Color fundus image
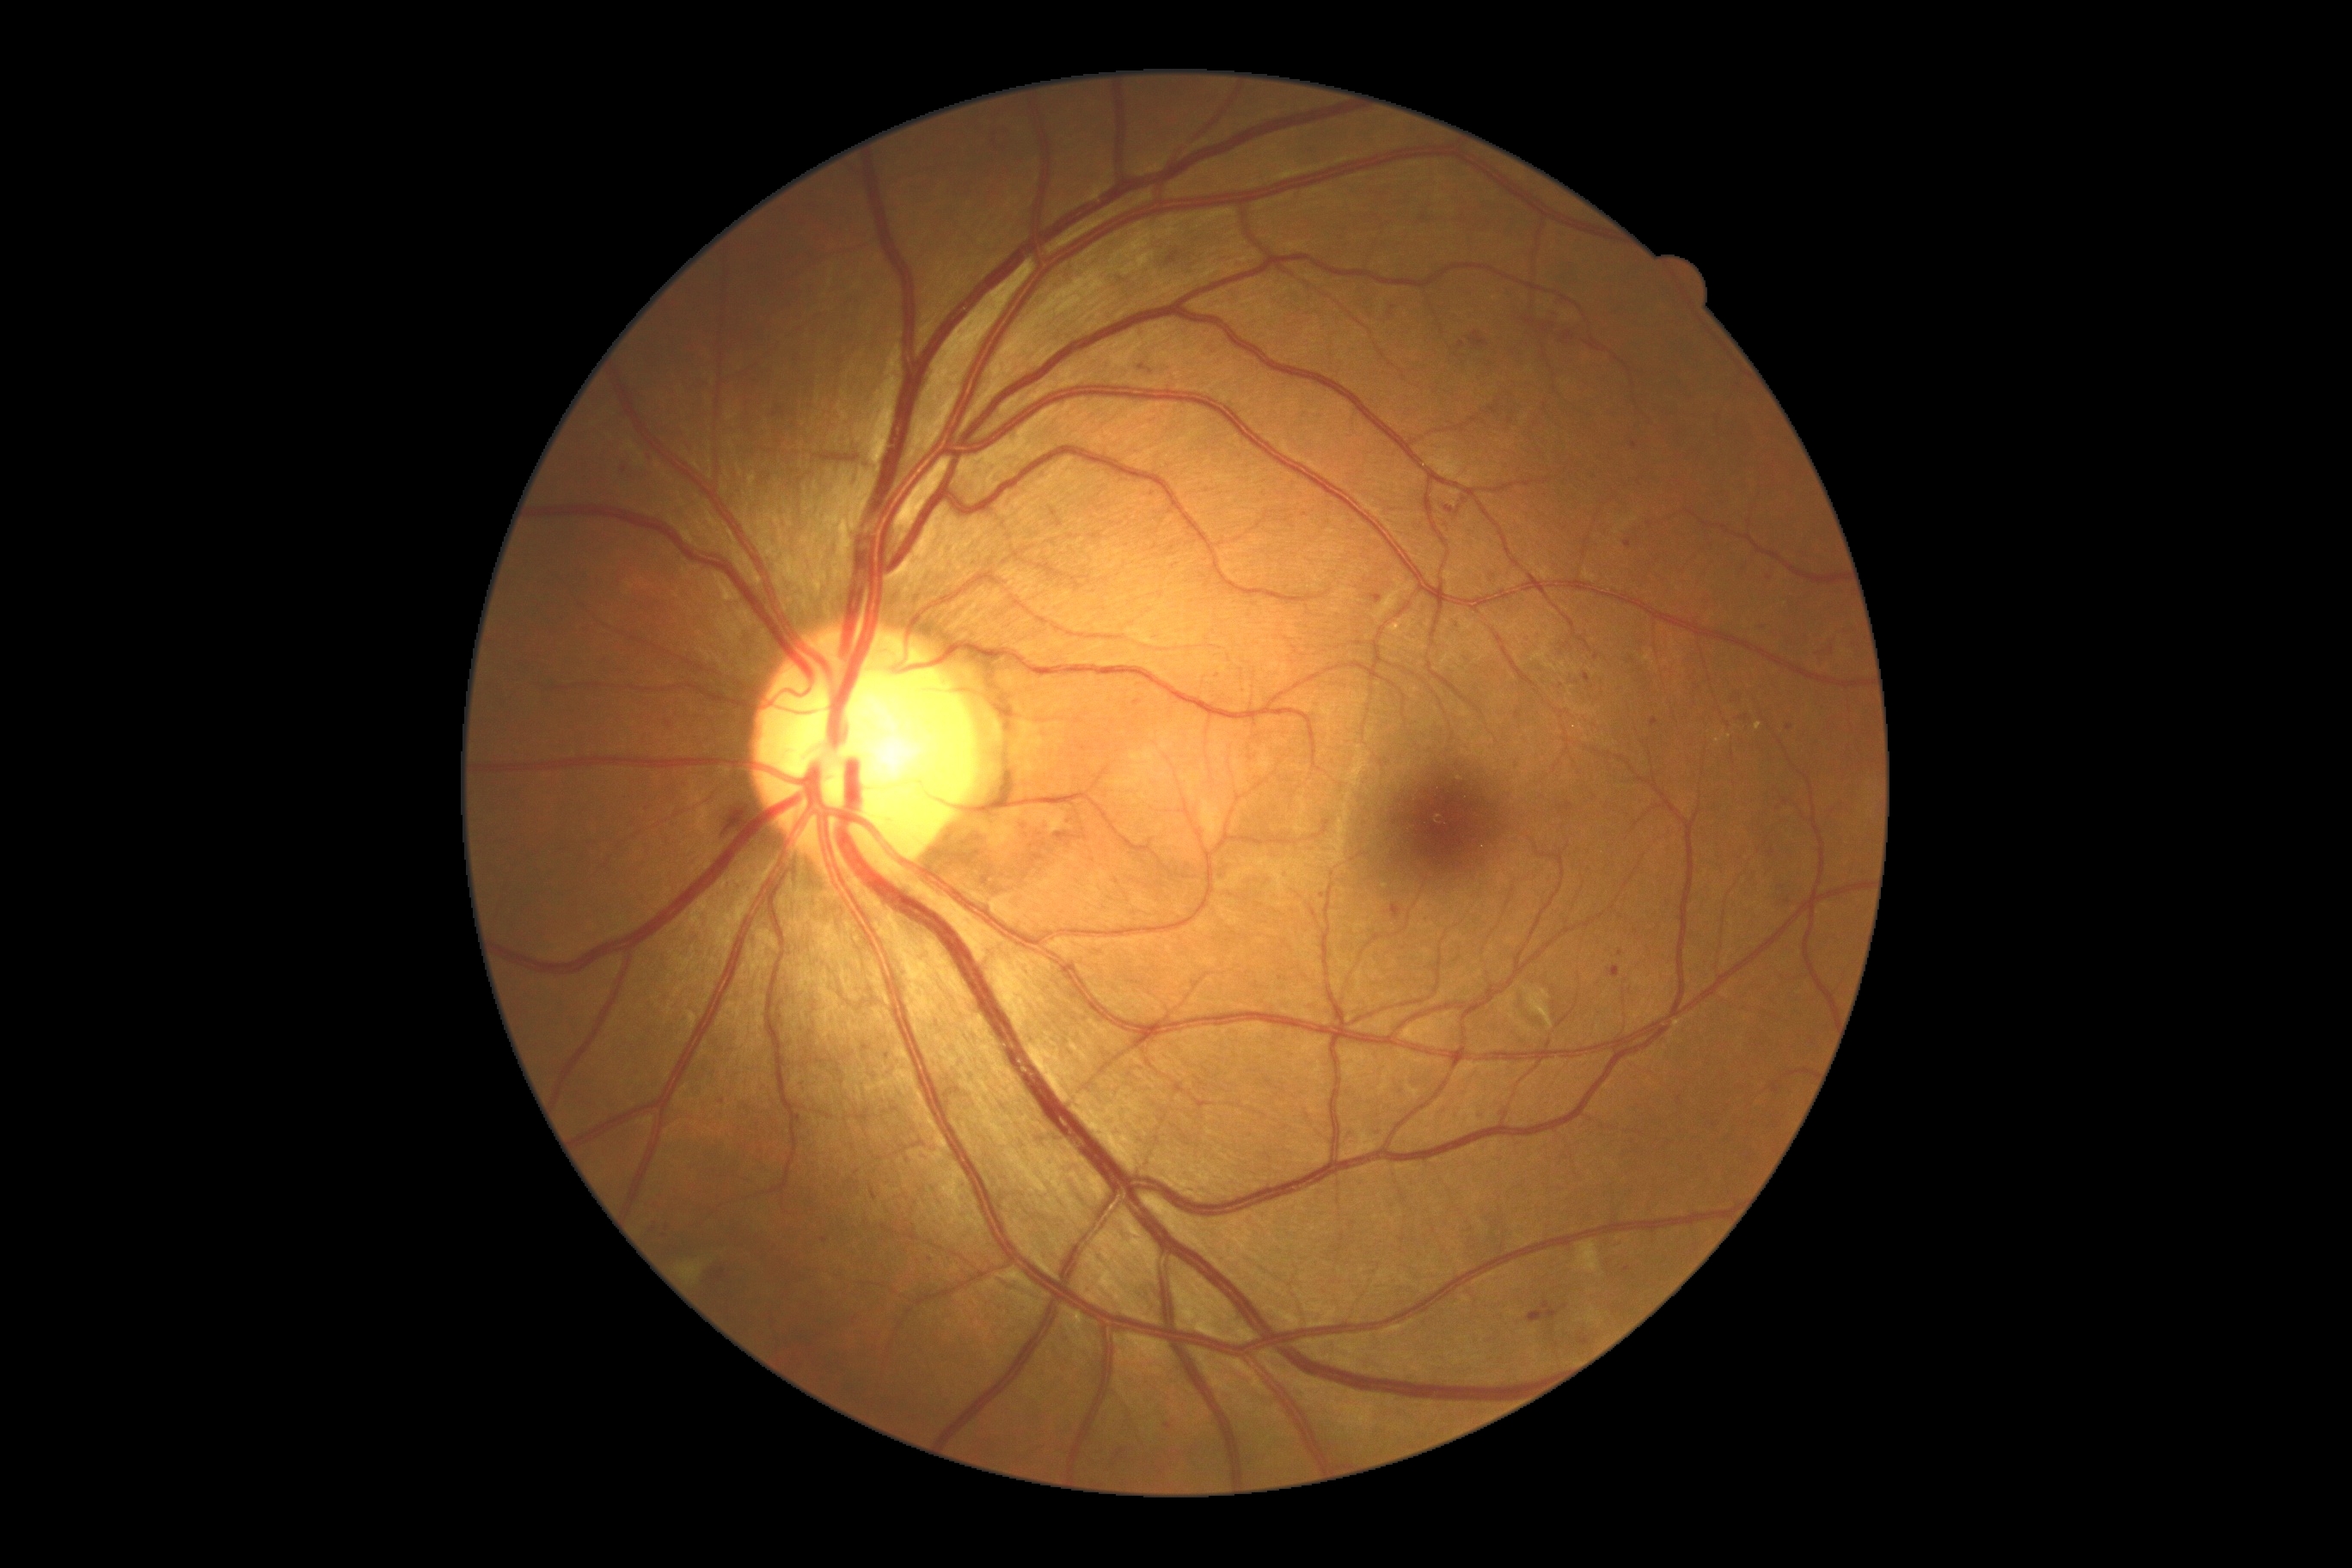

DR is 2/4
Representative lesions:
MAs (continued): x1=1595 y1=652 x2=1600 y2=661, x1=1369 y1=594 x2=1383 y2=604, x1=1624 y1=541 x2=1632 y2=549, x1=871 y1=1187 x2=878 y2=1201, x1=1165 y1=1423 x2=1173 y2=1430, x1=1055 y1=833 x2=1089 y2=843, x1=1560 y1=331 x2=1576 y2=343
Small MAs approximately at x=1465 y=501, x=654 y=1230, x=1047 y=827, x=1391 y=314, x=1150 y=372, x=1218 y=676, x=1138 y=703, x=1789 y=727